Optic disc-centered crop from a color fundus photograph
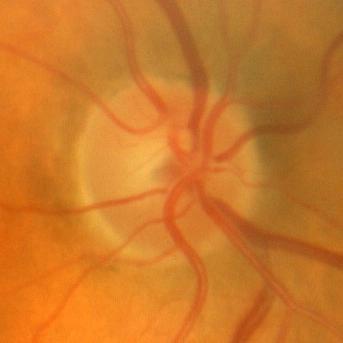 Impression = no glaucoma.